Posterior pole photograph; 45 degree fundus photograph — 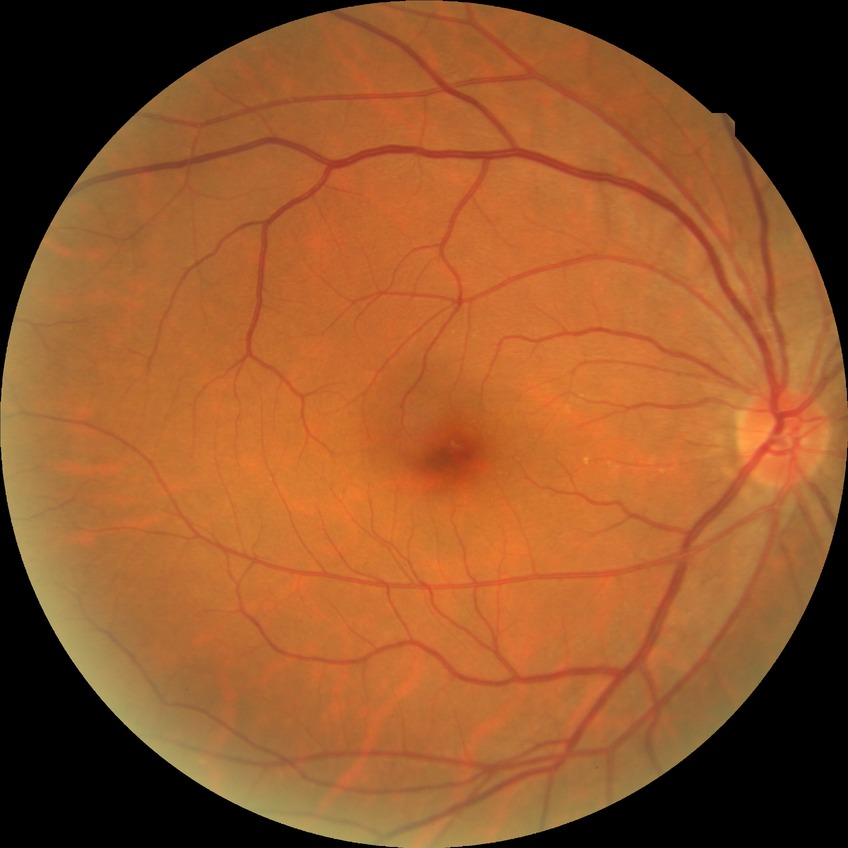 Diabetic retinopathy (DR): NDR (no diabetic retinopathy).